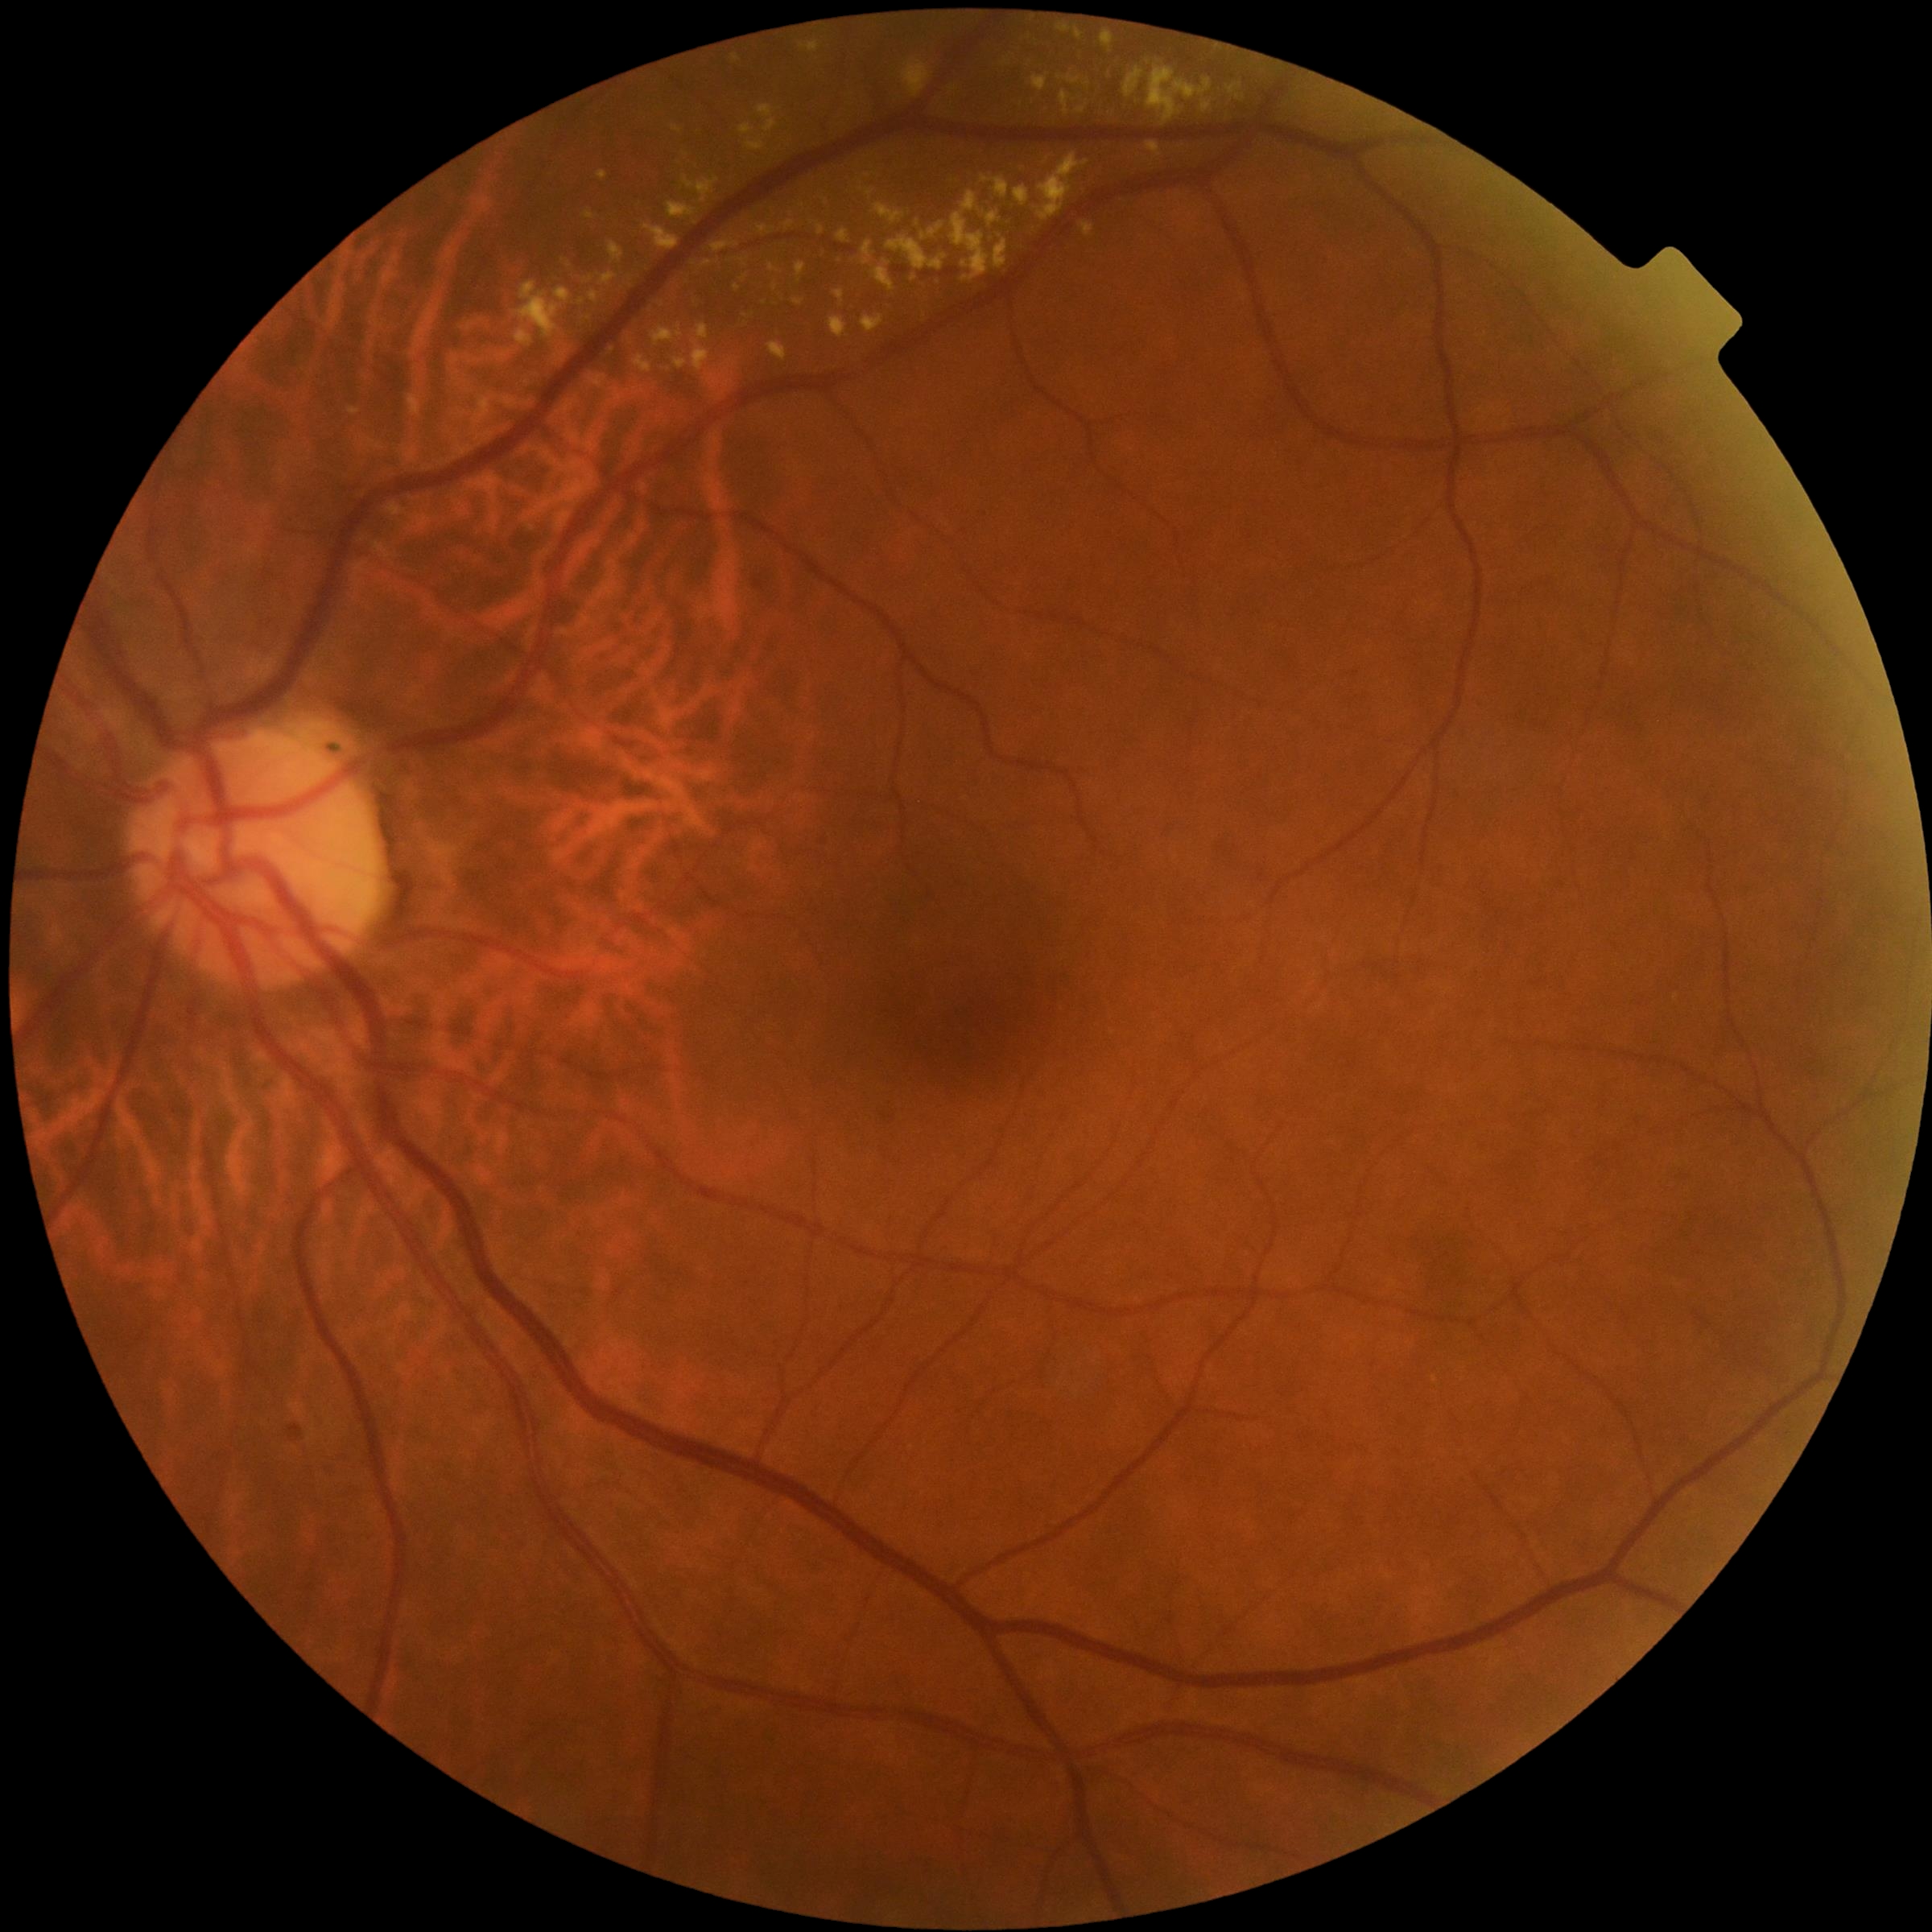 Diabetic retinopathy grade: 2
Selected lesions:
hard exudates (subset) = x1=993 y1=234 x2=1009 y2=270, x1=830 y1=317 x2=847 y2=340, x1=747 y1=138 x2=766 y2=151, x1=589 y1=291 x2=599 y2=303, x1=796 y1=262 x2=806 y2=279, x1=409 y1=396 x2=422 y2=416, x1=886 y1=234 x2=948 y2=272, x1=584 y1=212 x2=595 y2=219, x1=634 y1=357 x2=654 y2=374, x1=871 y1=261 x2=896 y2=292, x1=865 y1=191 x2=873 y2=196, x1=584 y1=278 x2=593 y2=285, x1=1102 y1=31 x2=1113 y2=48, x1=1104 y1=25 x2=1116 y2=30
Smaller hard exudates around (x=916, y=278), (x=727, y=372), (x=685, y=155)